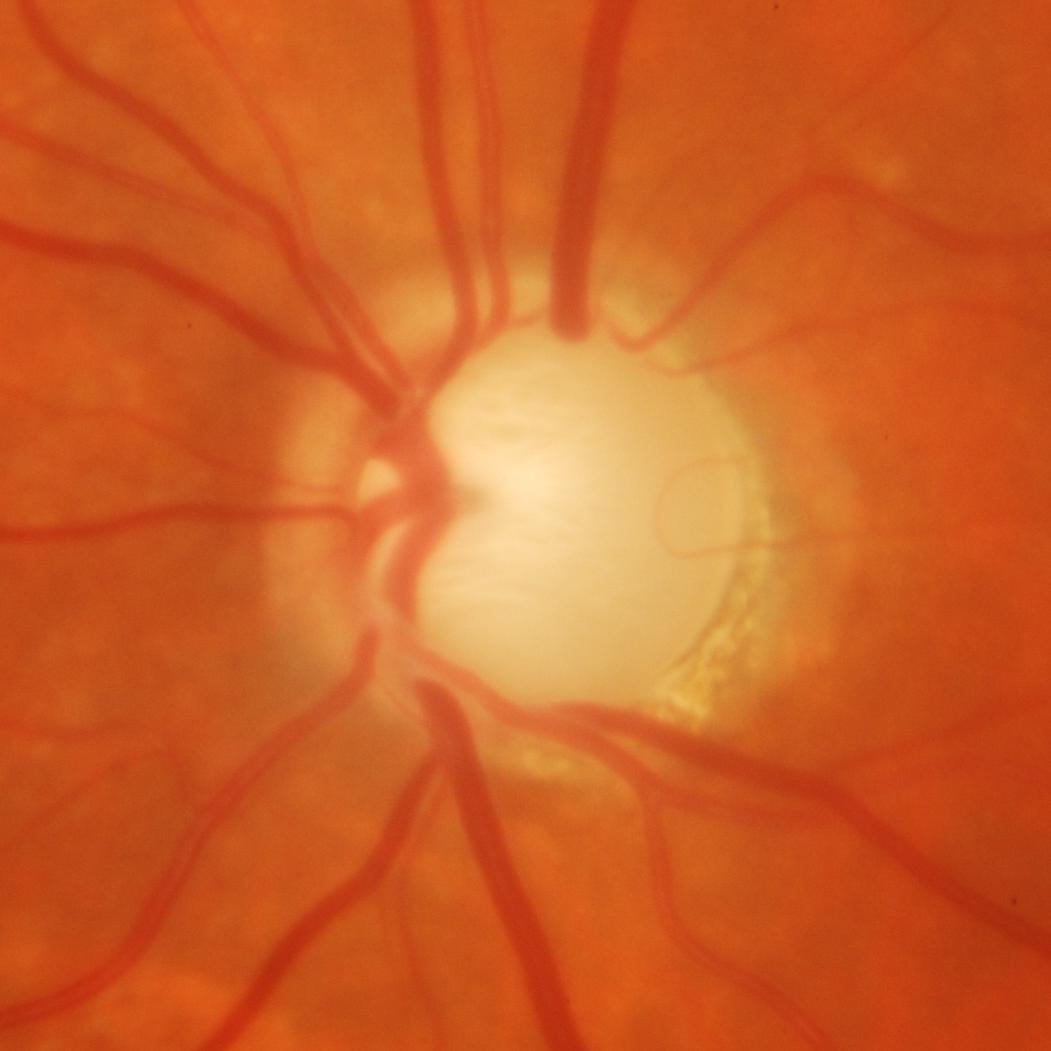 Glaucoma is present.
Glaucomatous damage to the optic nerve.